Camera: NIDEK AFC-230. 45 degree fundus photograph. 848 x 848 pixels. Color fundus image.
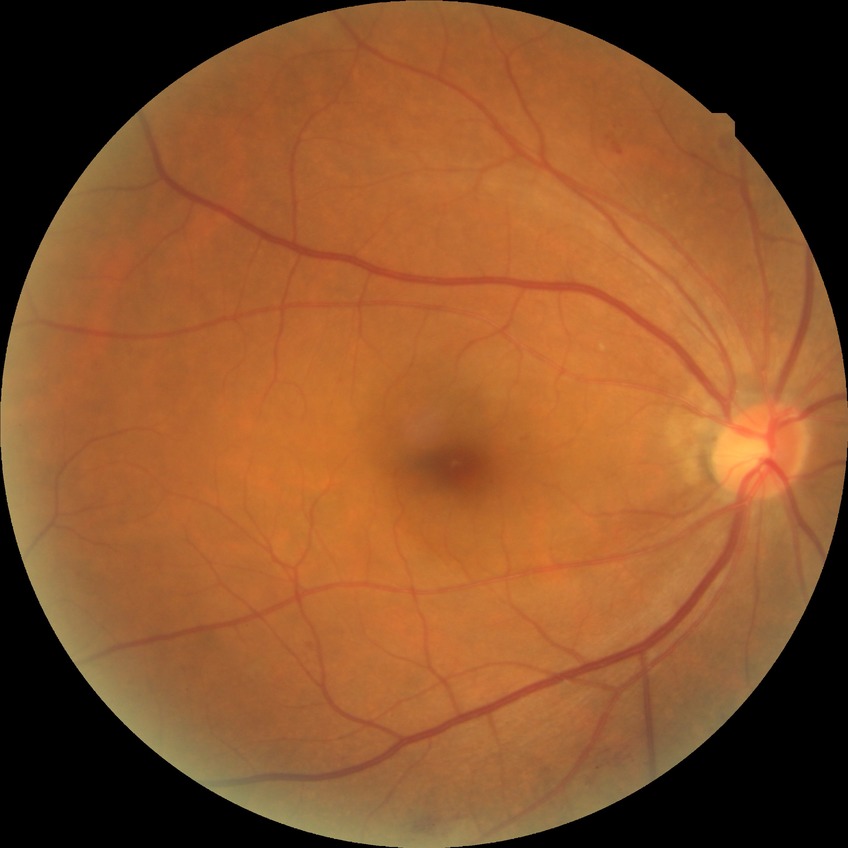 {
  "davis_grade": "PPDR (pre-proliferative diabetic retinopathy)"
}